NIDEK AFC-230 · without pupil dilation · diabetic retinopathy graded by the modified Davis classification: 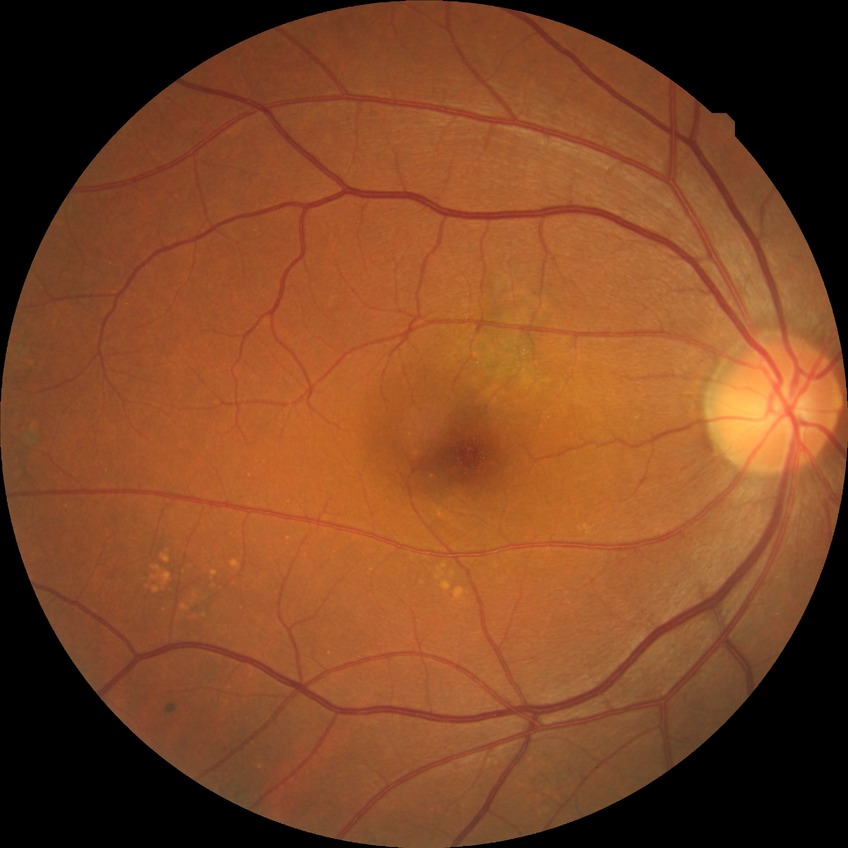 diabetic retinopathy (DR) = NDR (no diabetic retinopathy).